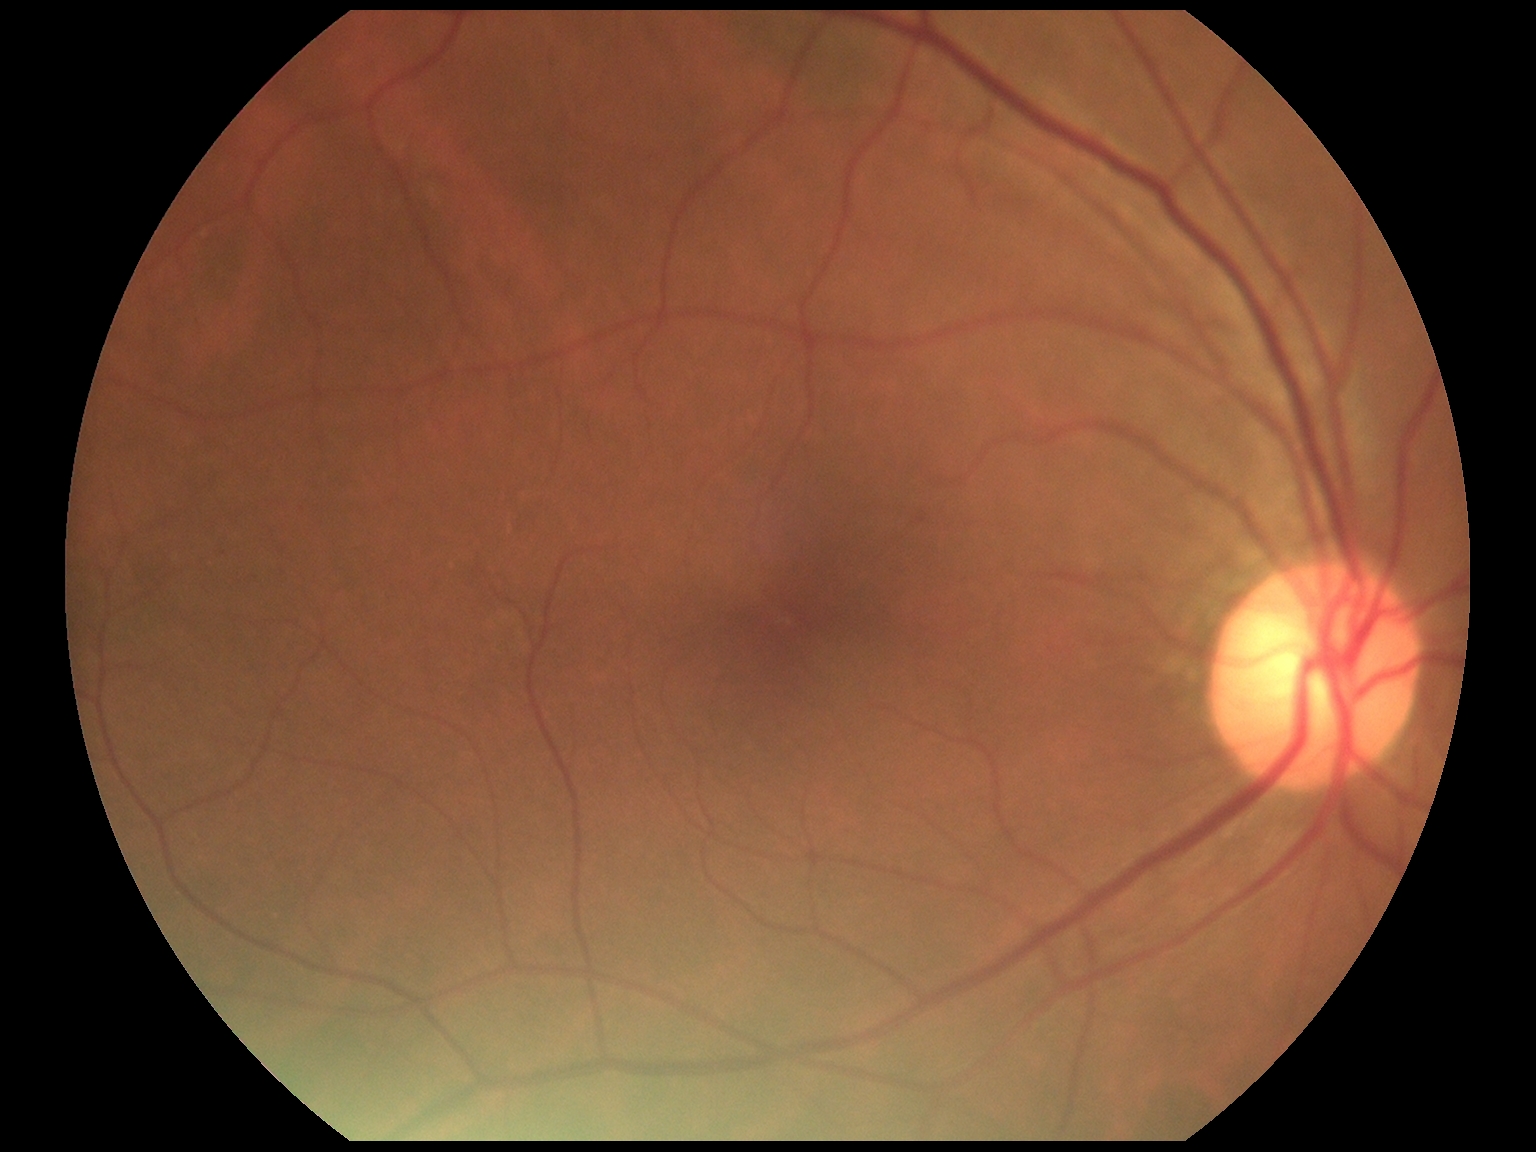
Diabetic retinopathy (DR) is no apparent diabetic retinopathy (grade 0) — no visible signs of diabetic retinopathy.